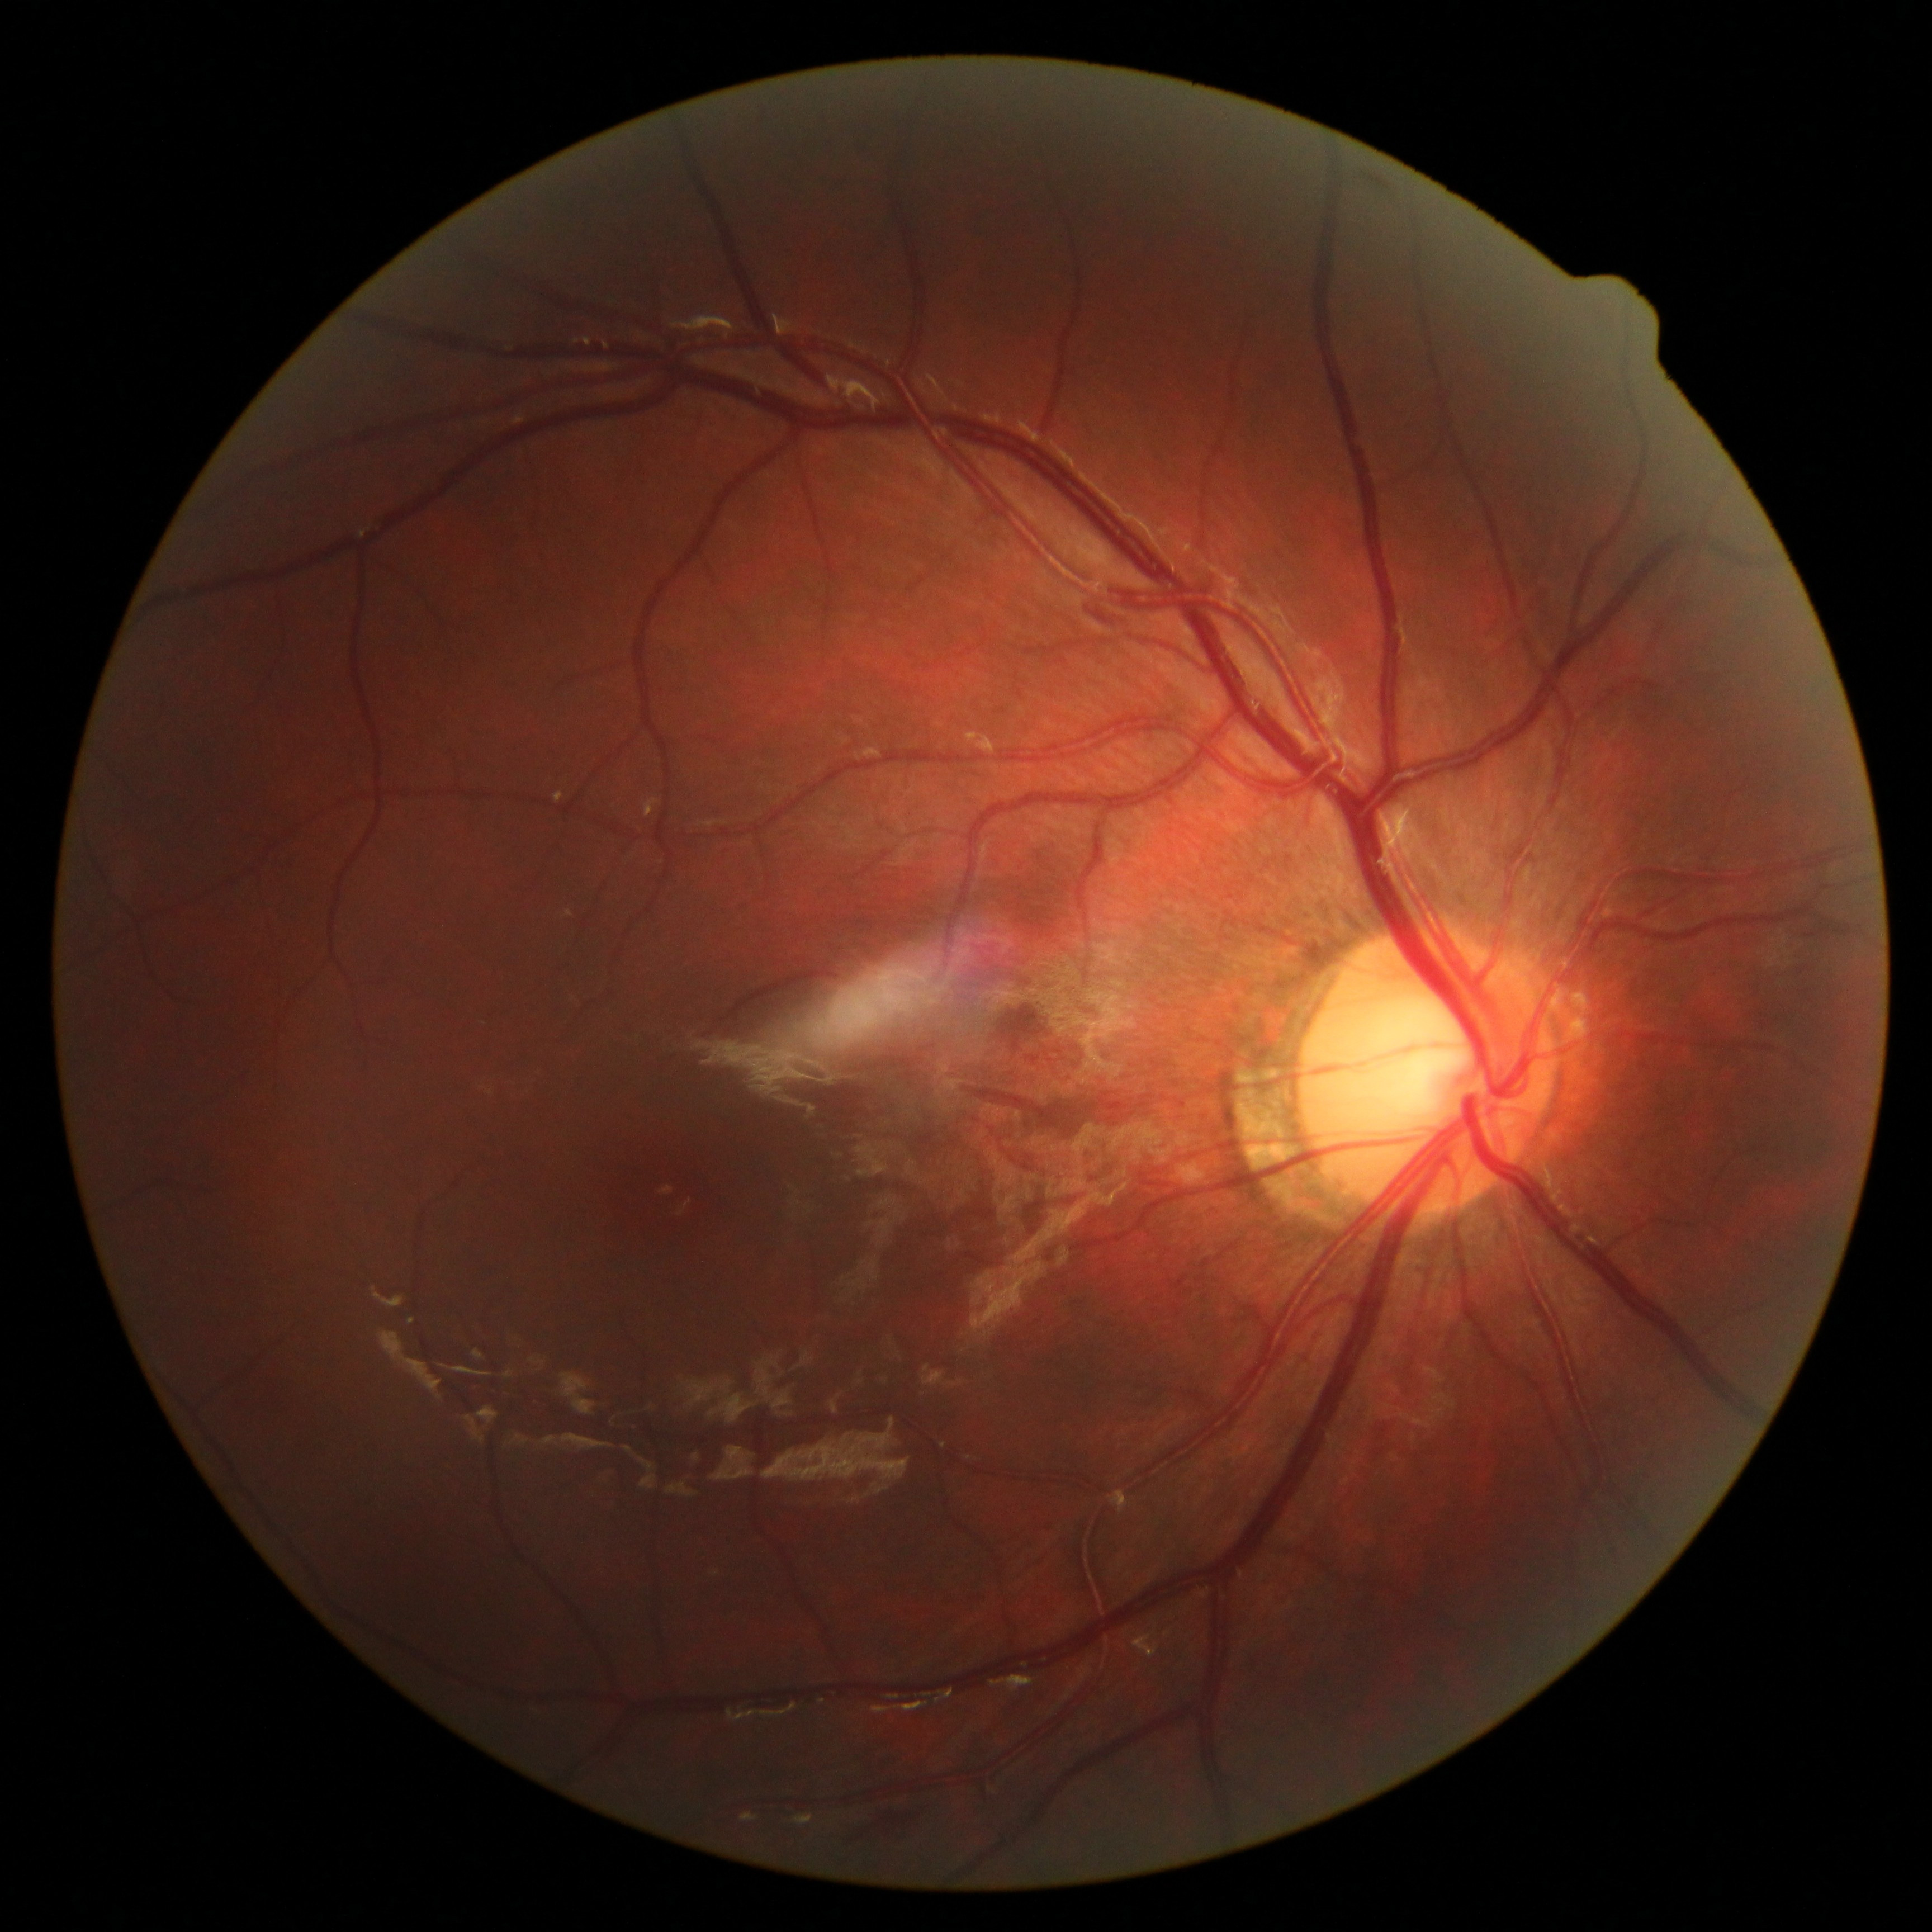   dr_category: non-proliferative diabetic retinopathy
  dr_grade: 2 (moderate NPDR)